Infant wide-field retinal image; 130° field of view (Clarity RetCam 3)
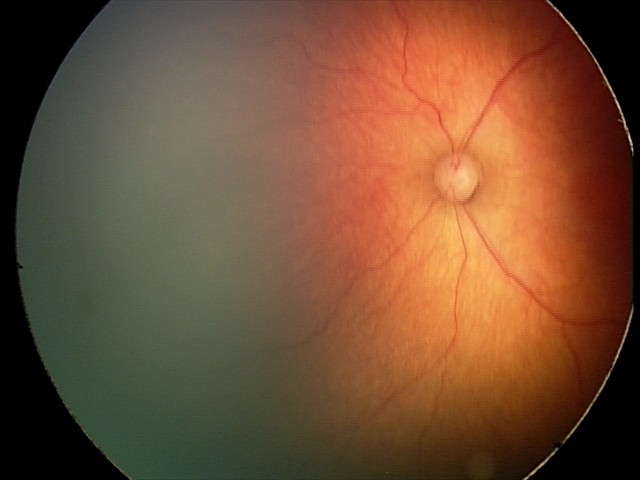

Finding: retinopathy of prematurity (ROP) stage 2.